Fundus photo; 848x848.
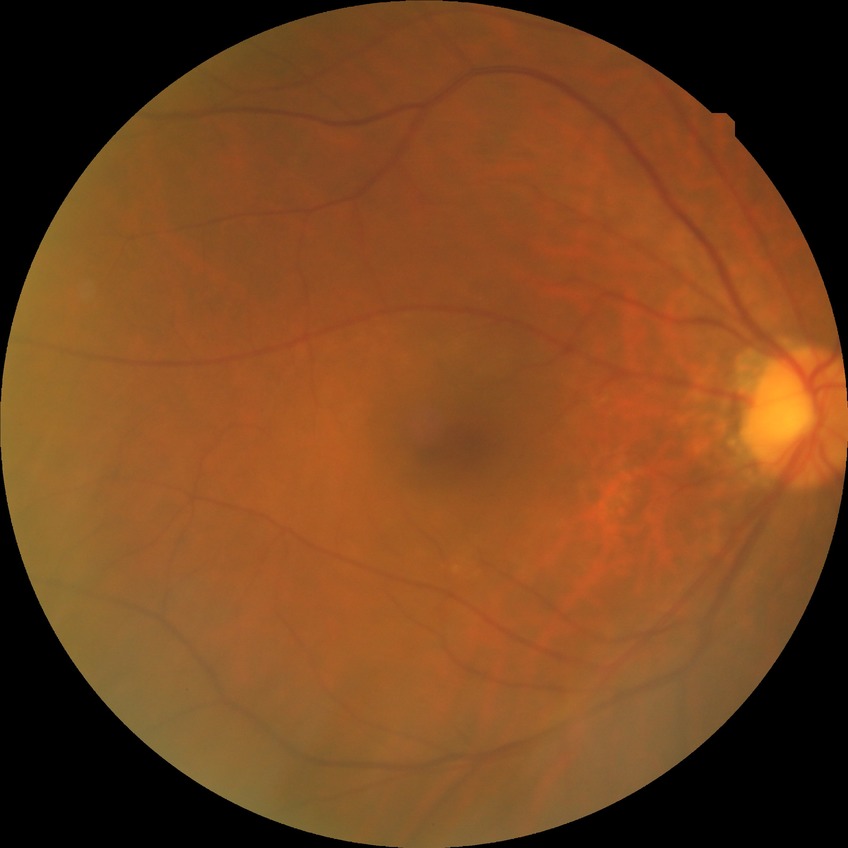

{
  "dr_impression": "no apparent DR",
  "davis_grade": "NDR"
}